45° field of view
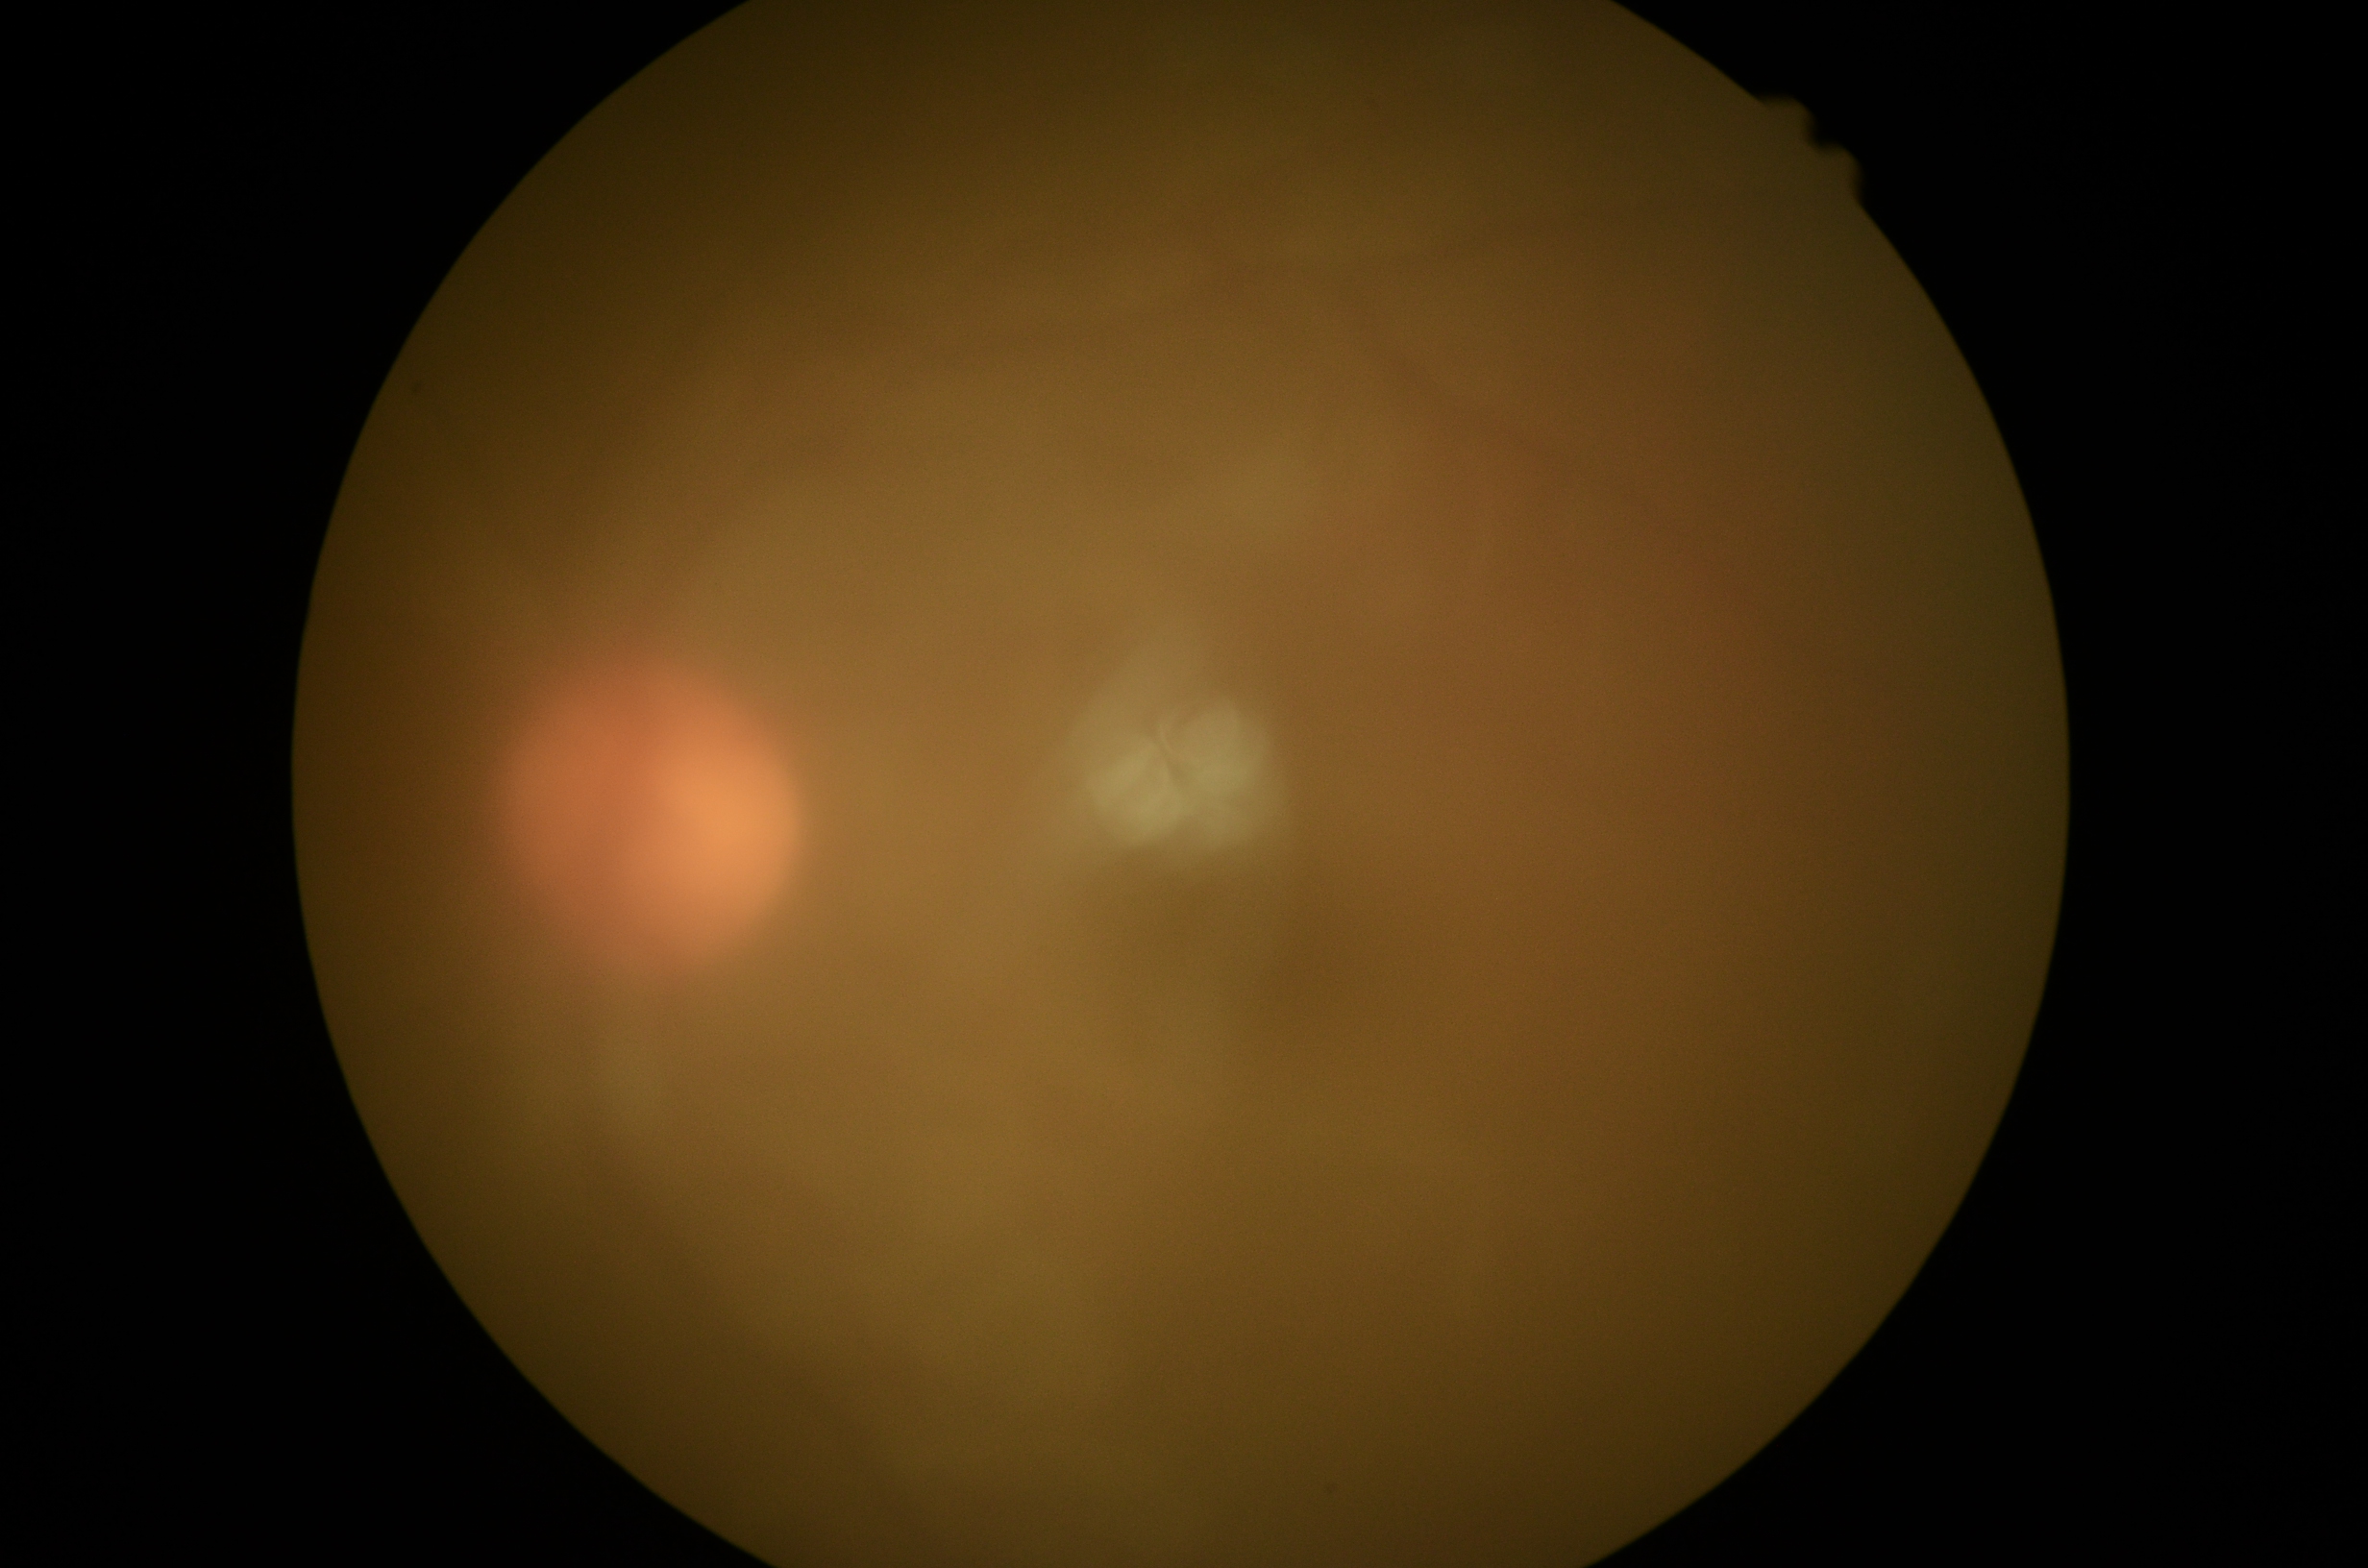 Diabetic retinopathy (DR): ungradable. The image cannot be graded for diabetic retinopathy.